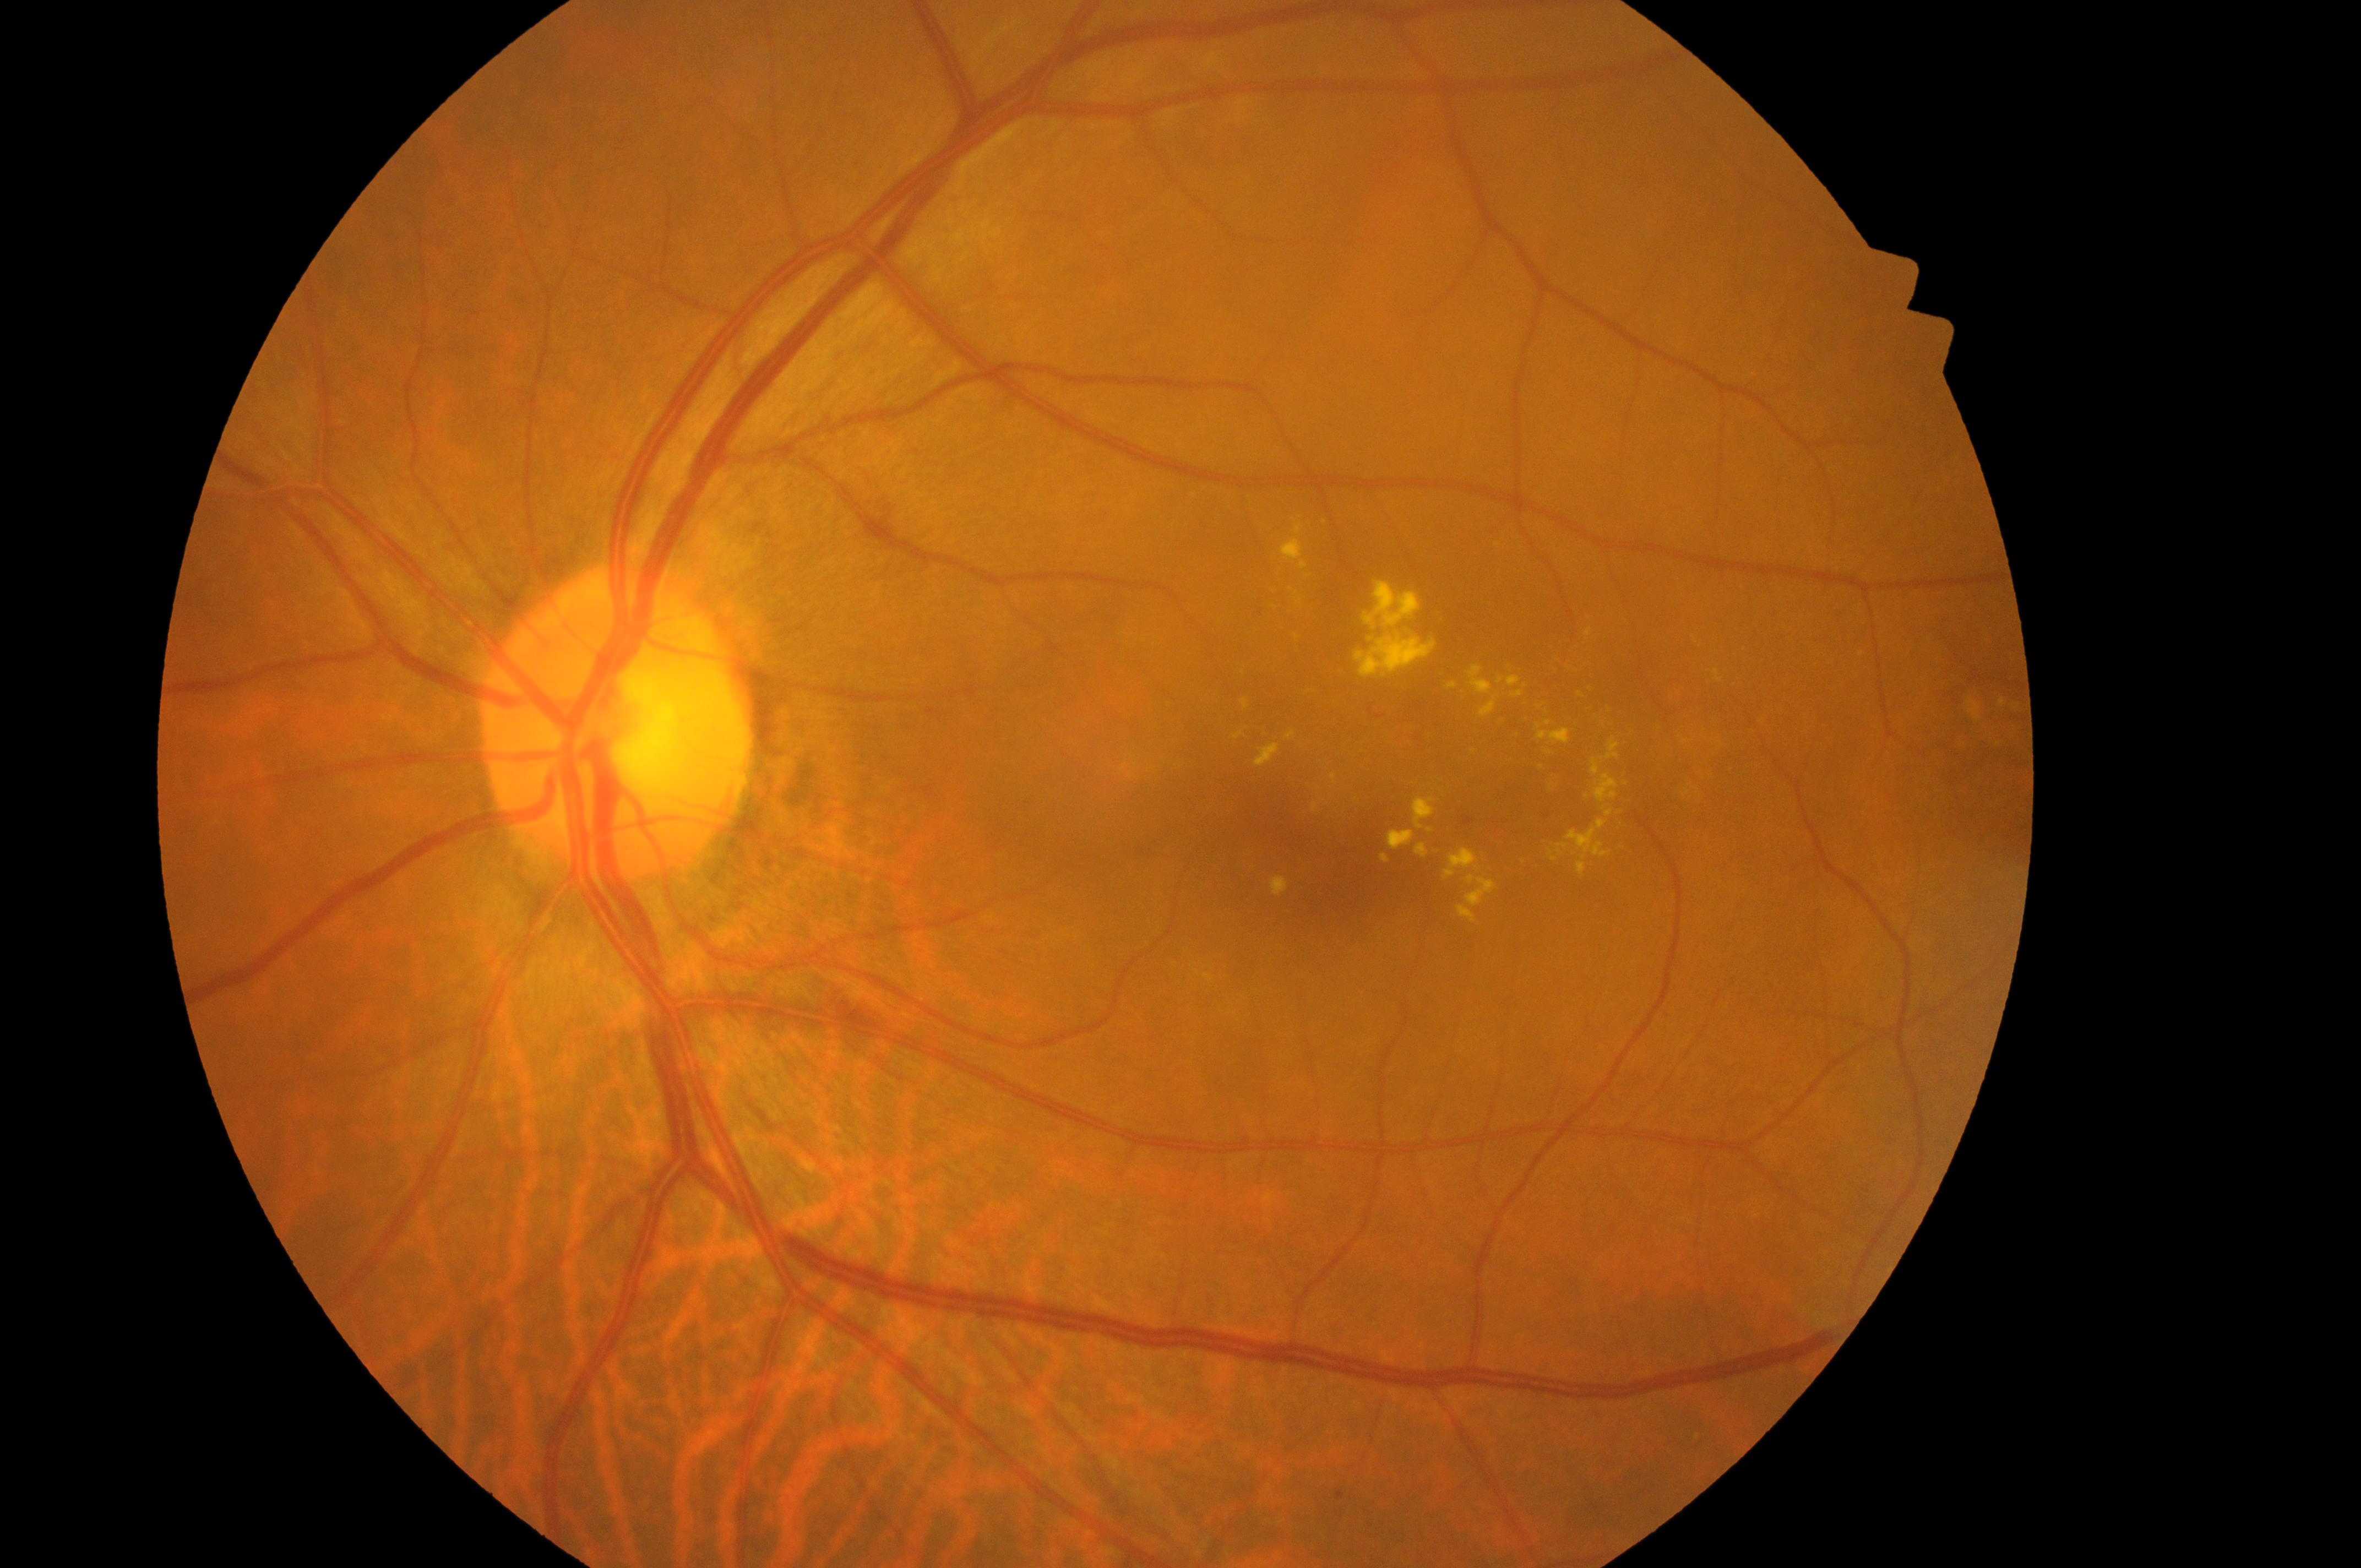

Diabetic macular edema (DME): high risk (grade 2) — hard exudates within one disc diameter of the macula center. The retinopathy is classified as non-proliferative diabetic retinopathy. Diabetic retinopathy (DR) is grade 2 (moderate NPDR) — more than just microaneurysms but less than severe NPDR. Disc center located at (610, 736). Fovea located at (1324, 835). The image shows the left eye.